Wide-field fundus photograph of an infant; 1440x1080; camera: Natus RetCam Envision (130° FOV): 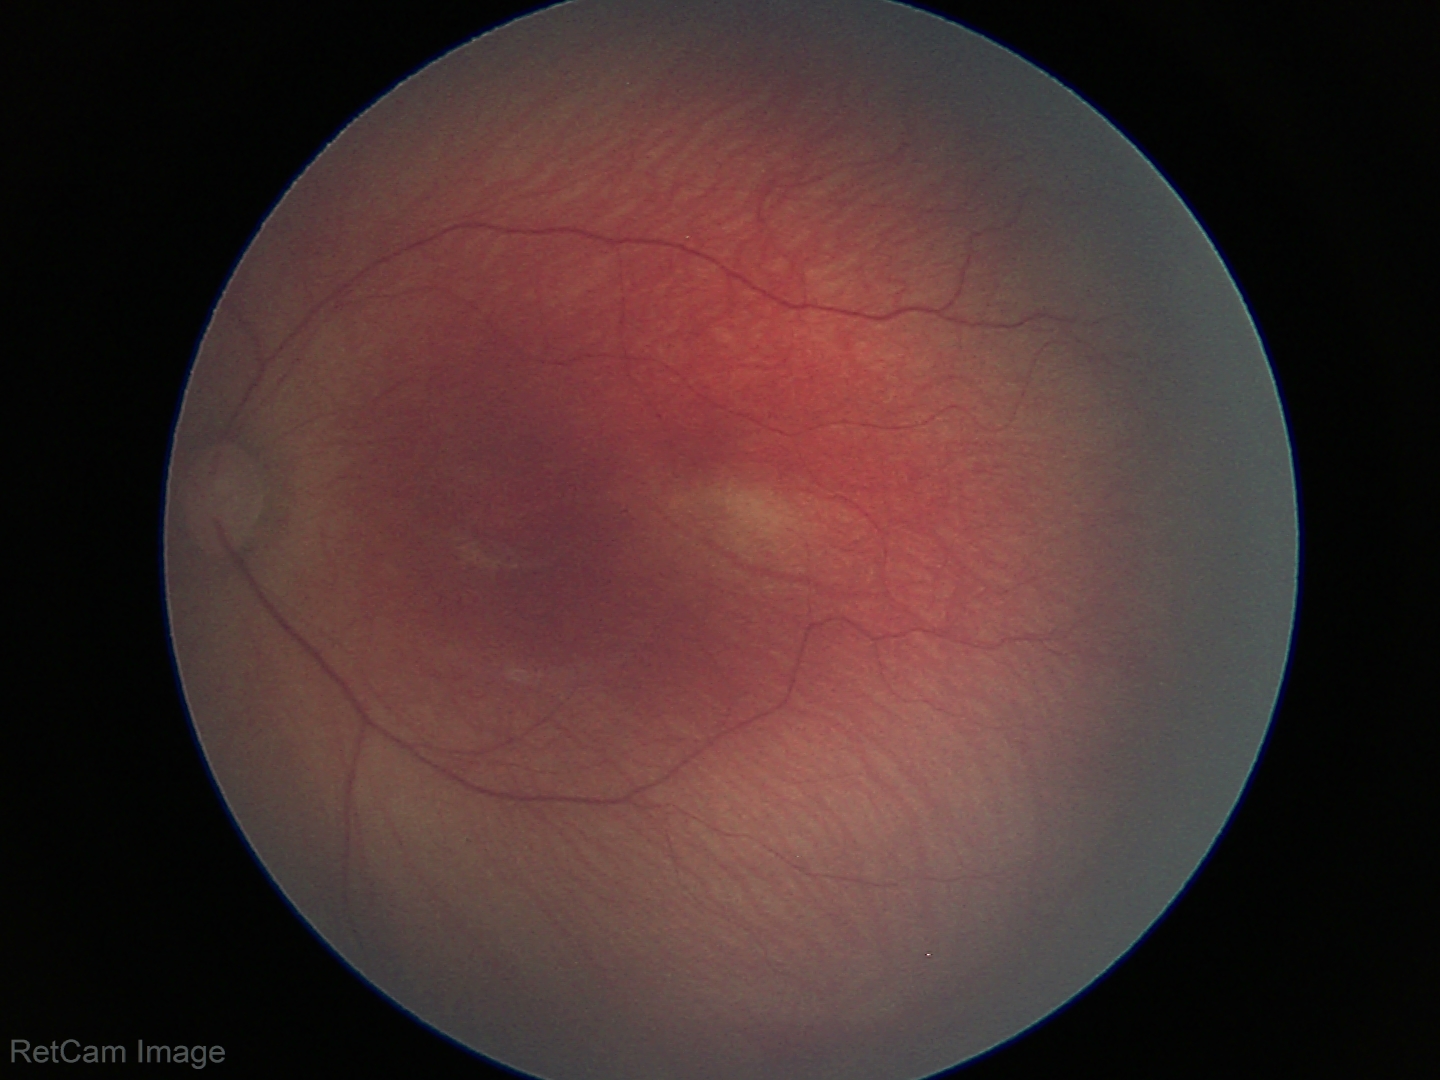

Examination diagnosed as retinopathy of prematurity (ROP) stage 1.
Without plus disease.